2346x1568px · FOV: 45 degrees.
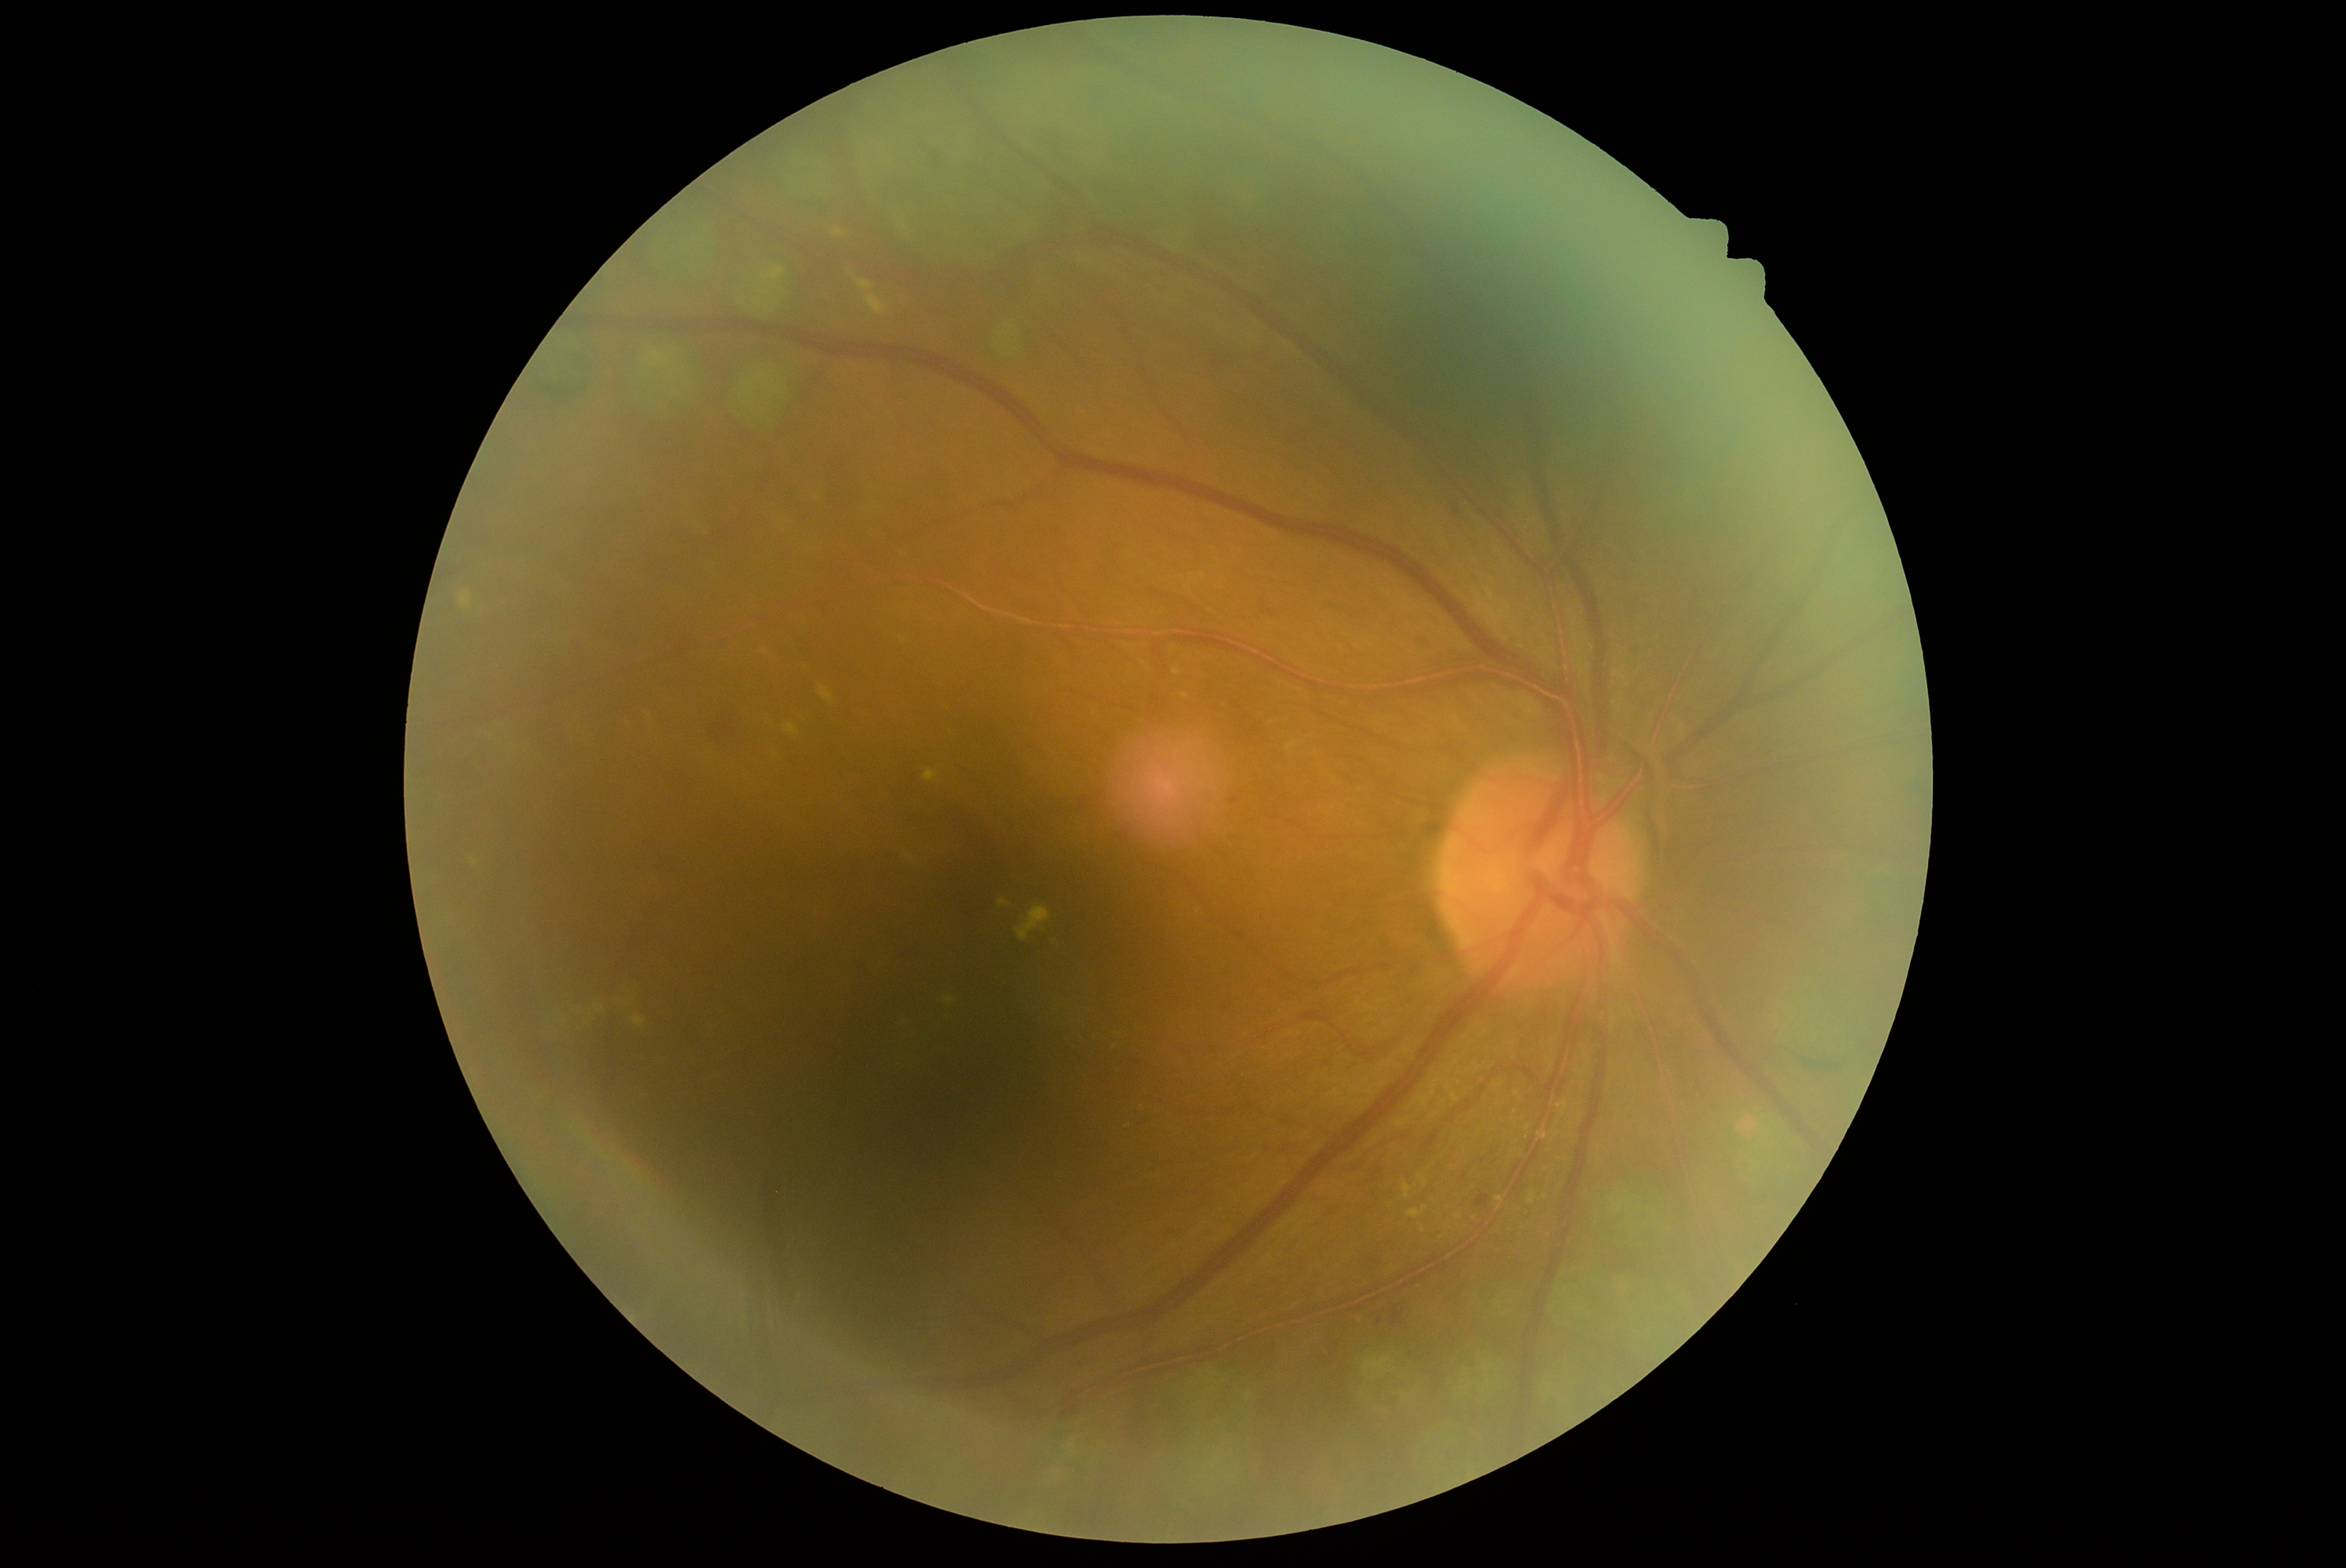

Disease class: non-proliferative diabetic retinopathy.
Diabetic retinopathy is grade 2.